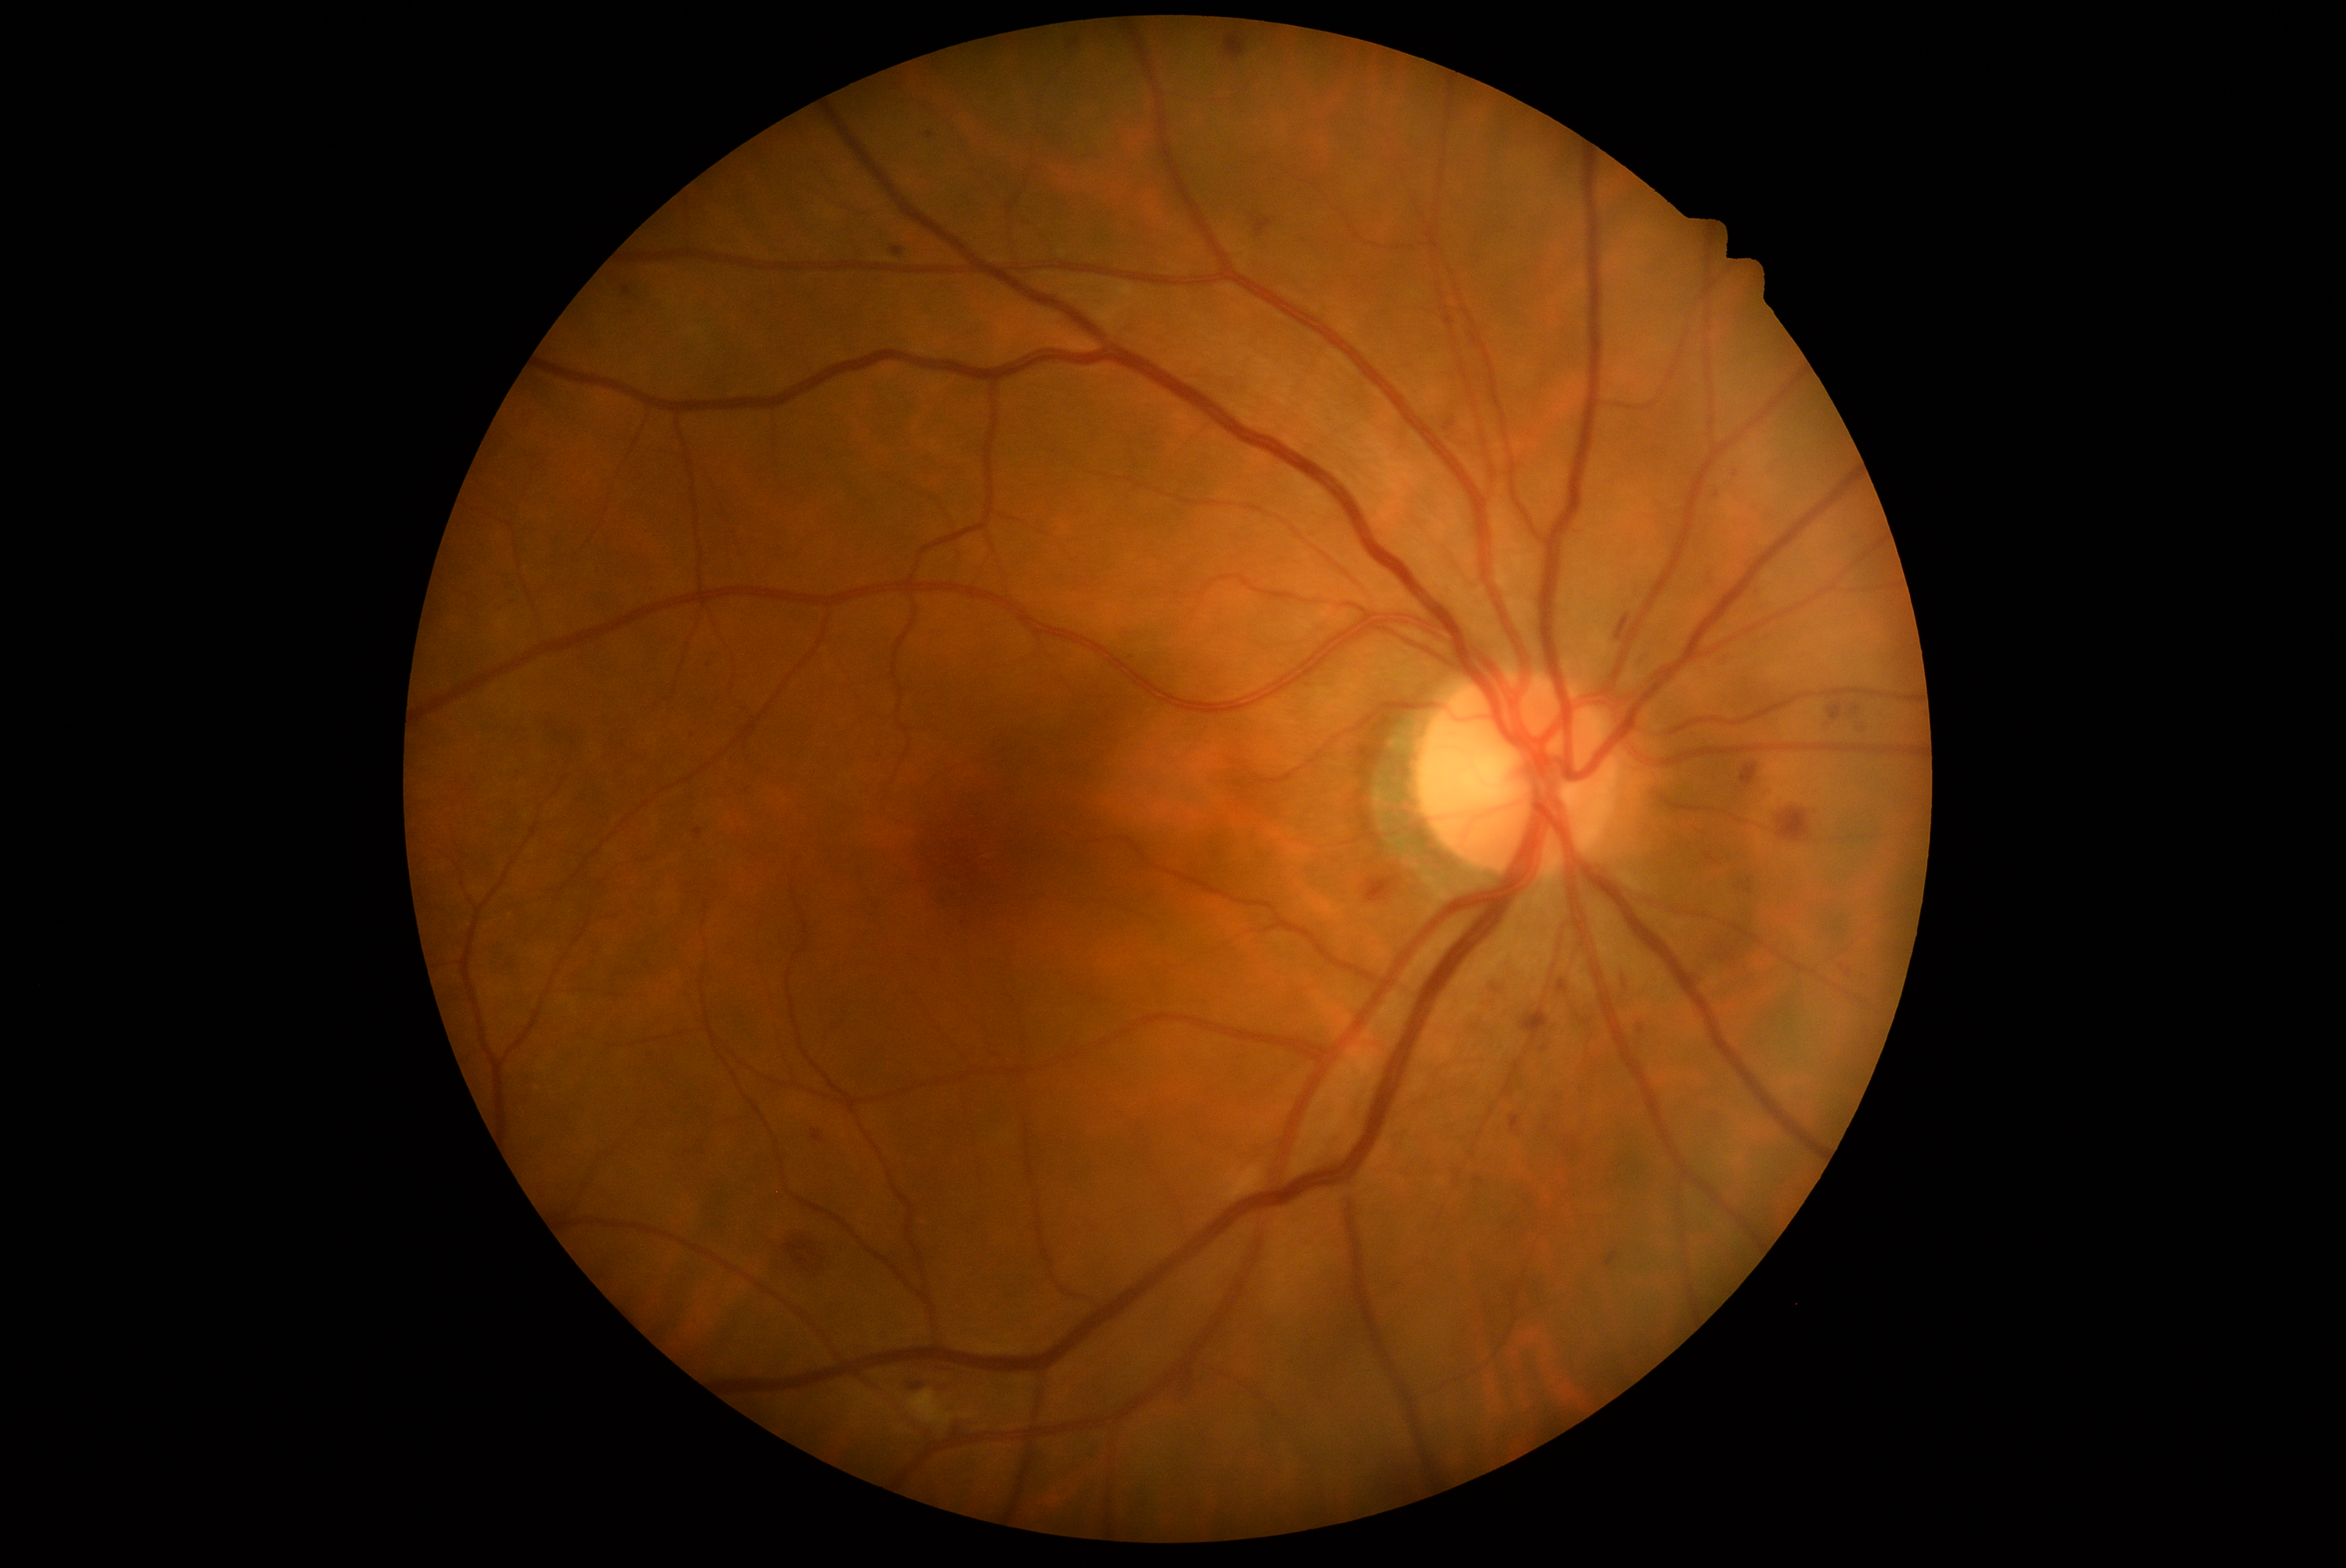
DR severity = moderate non-proliferative diabetic retinopathy (grade 2) — more than just microaneurysms but less than severe NPDR.